Nonmydriatic fundus photograph.
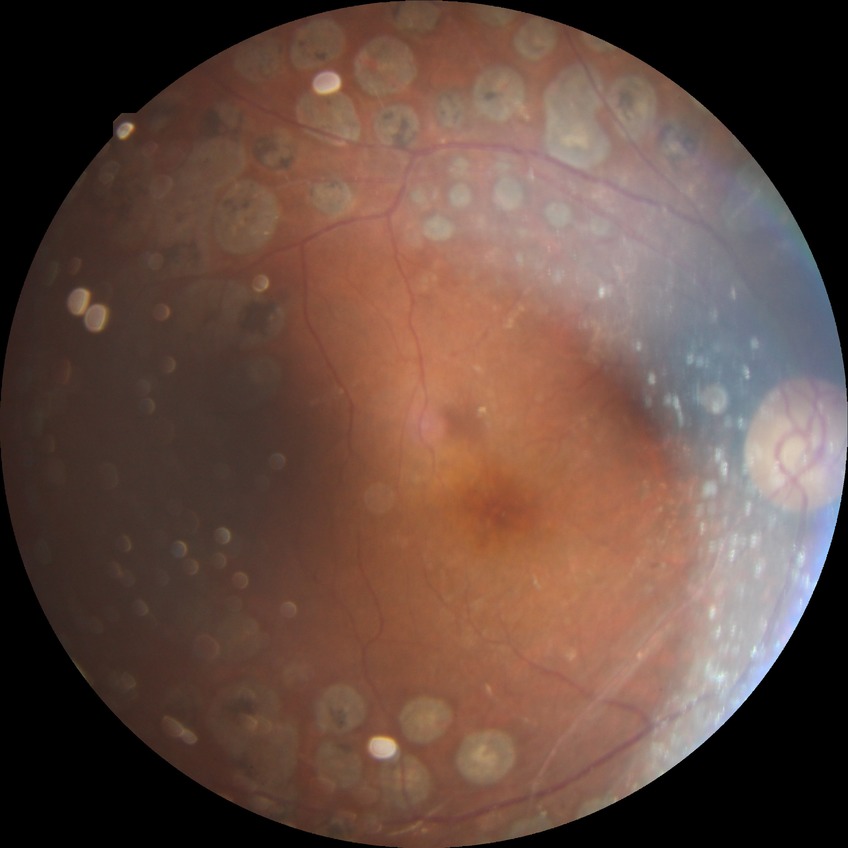

retinopathy grade = proliferative diabetic retinopathy